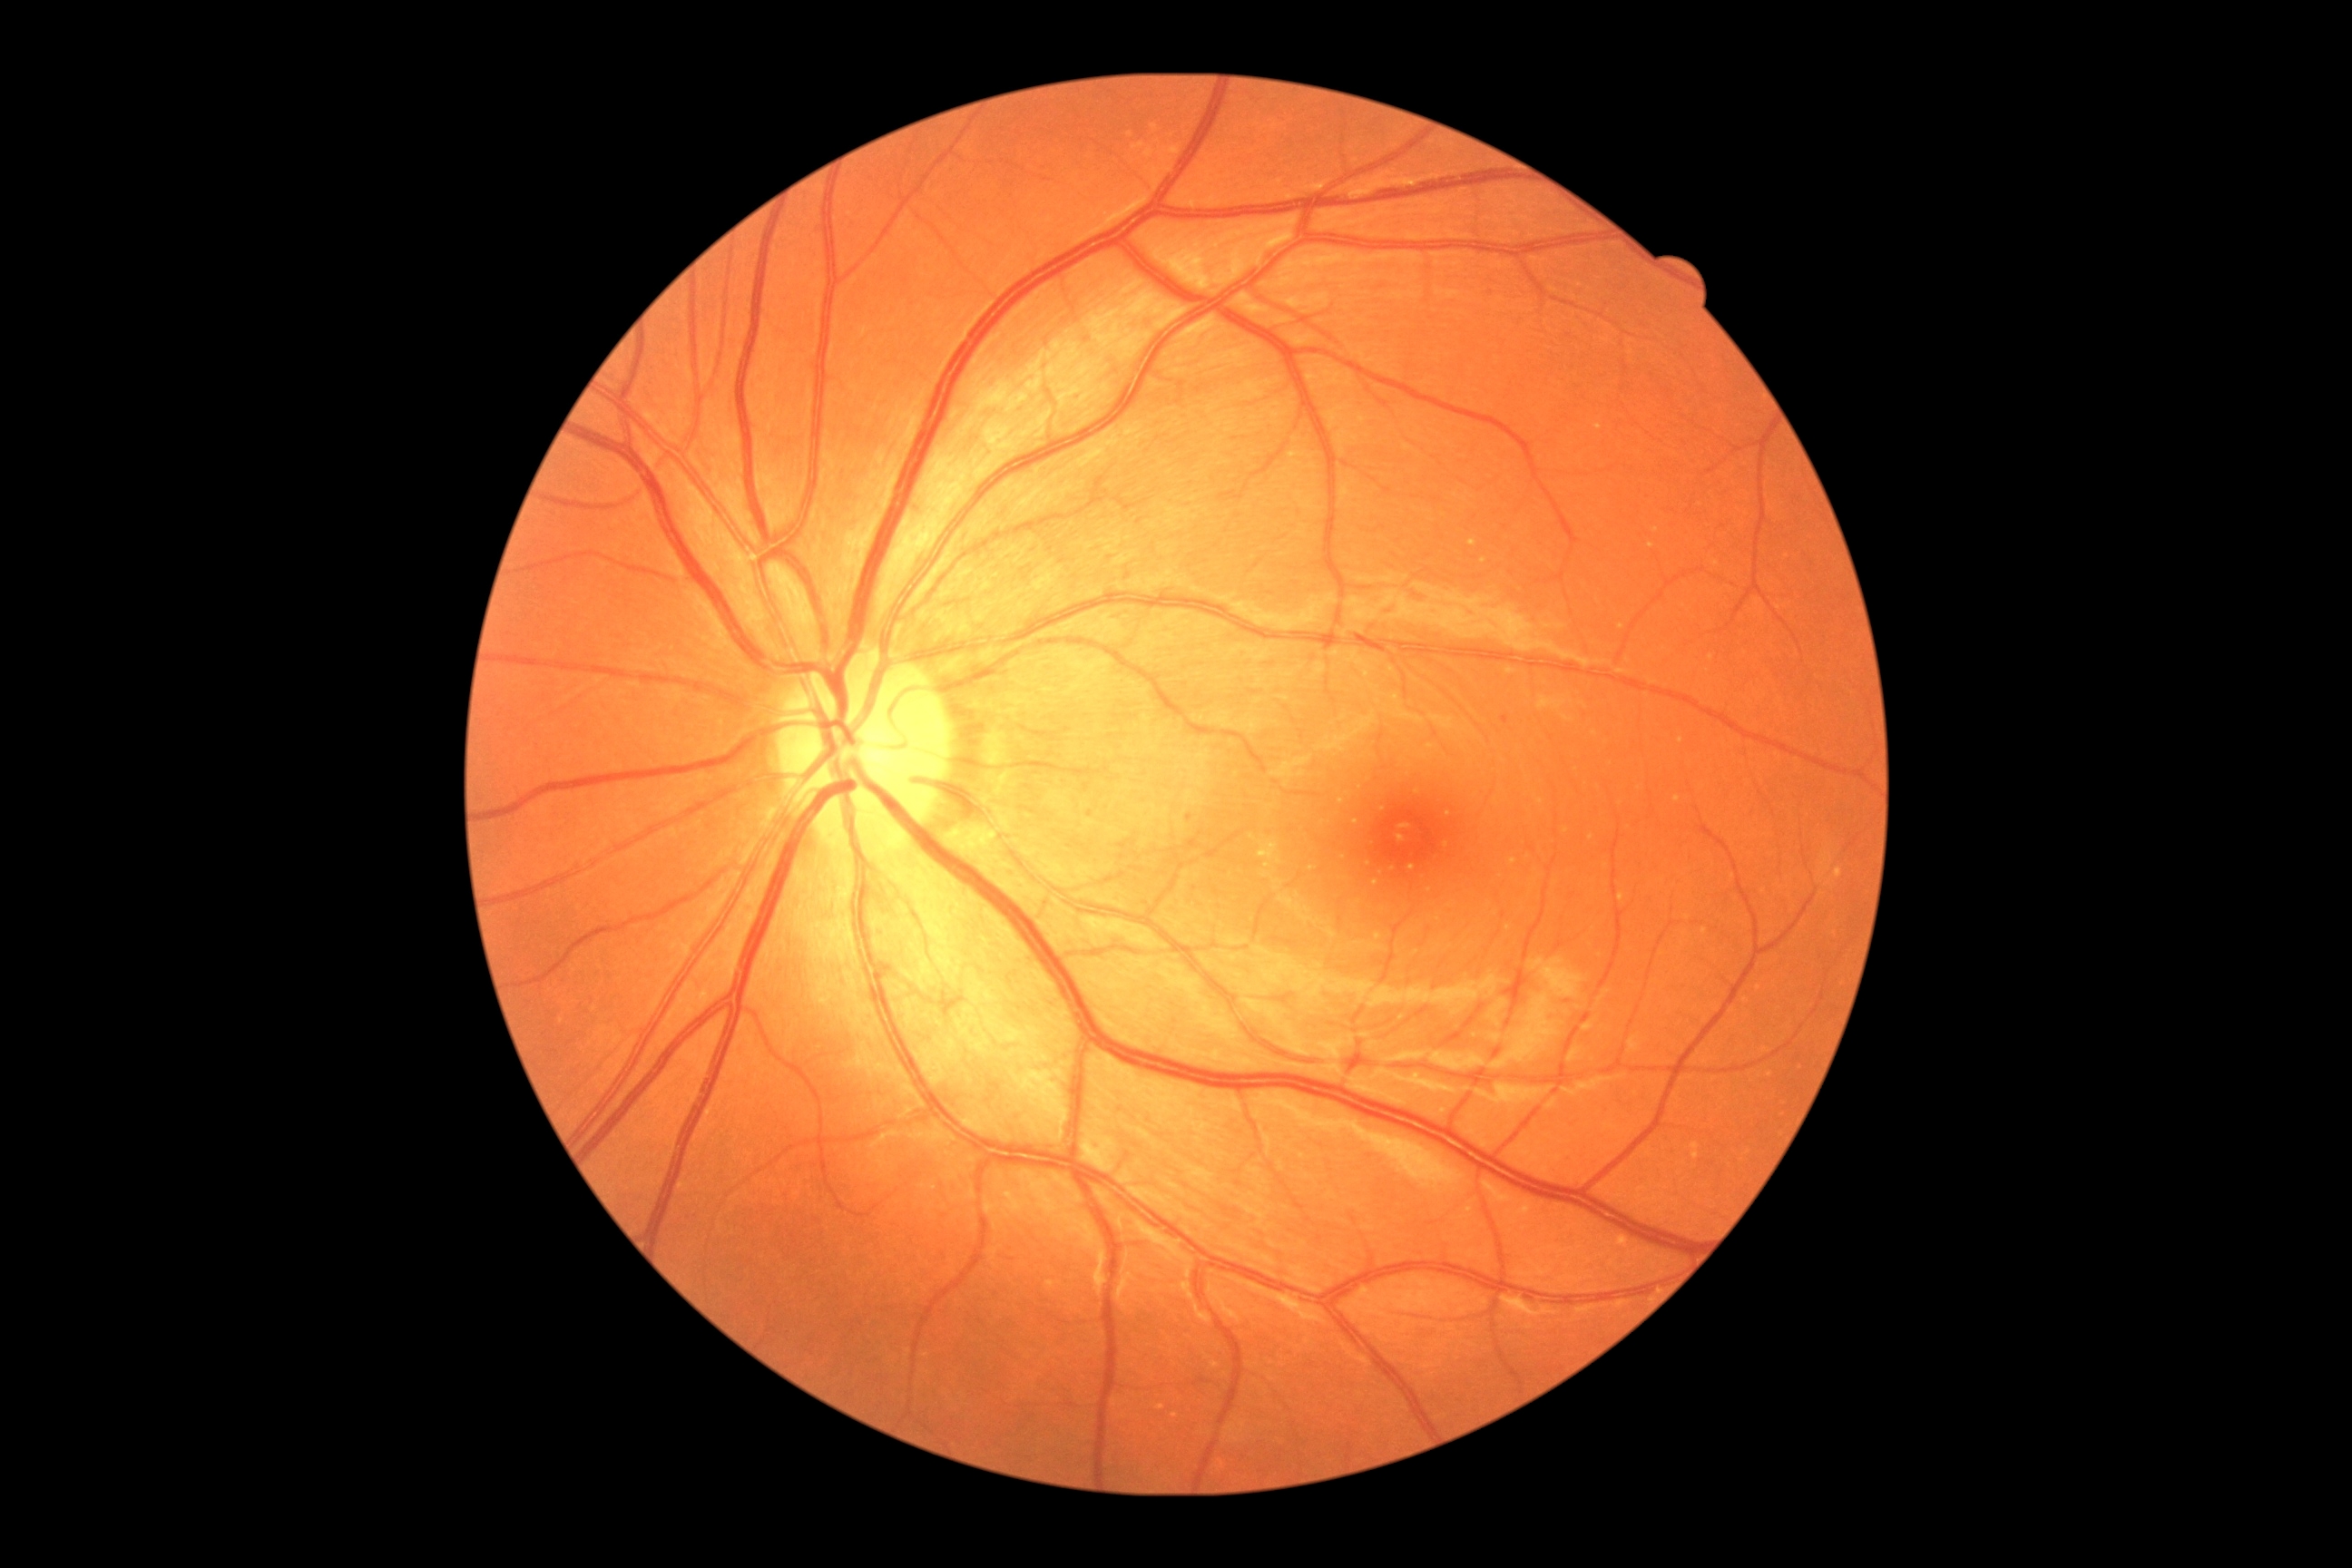
{
  "dr_grade": "grade 1 (mild NPDR)"
}